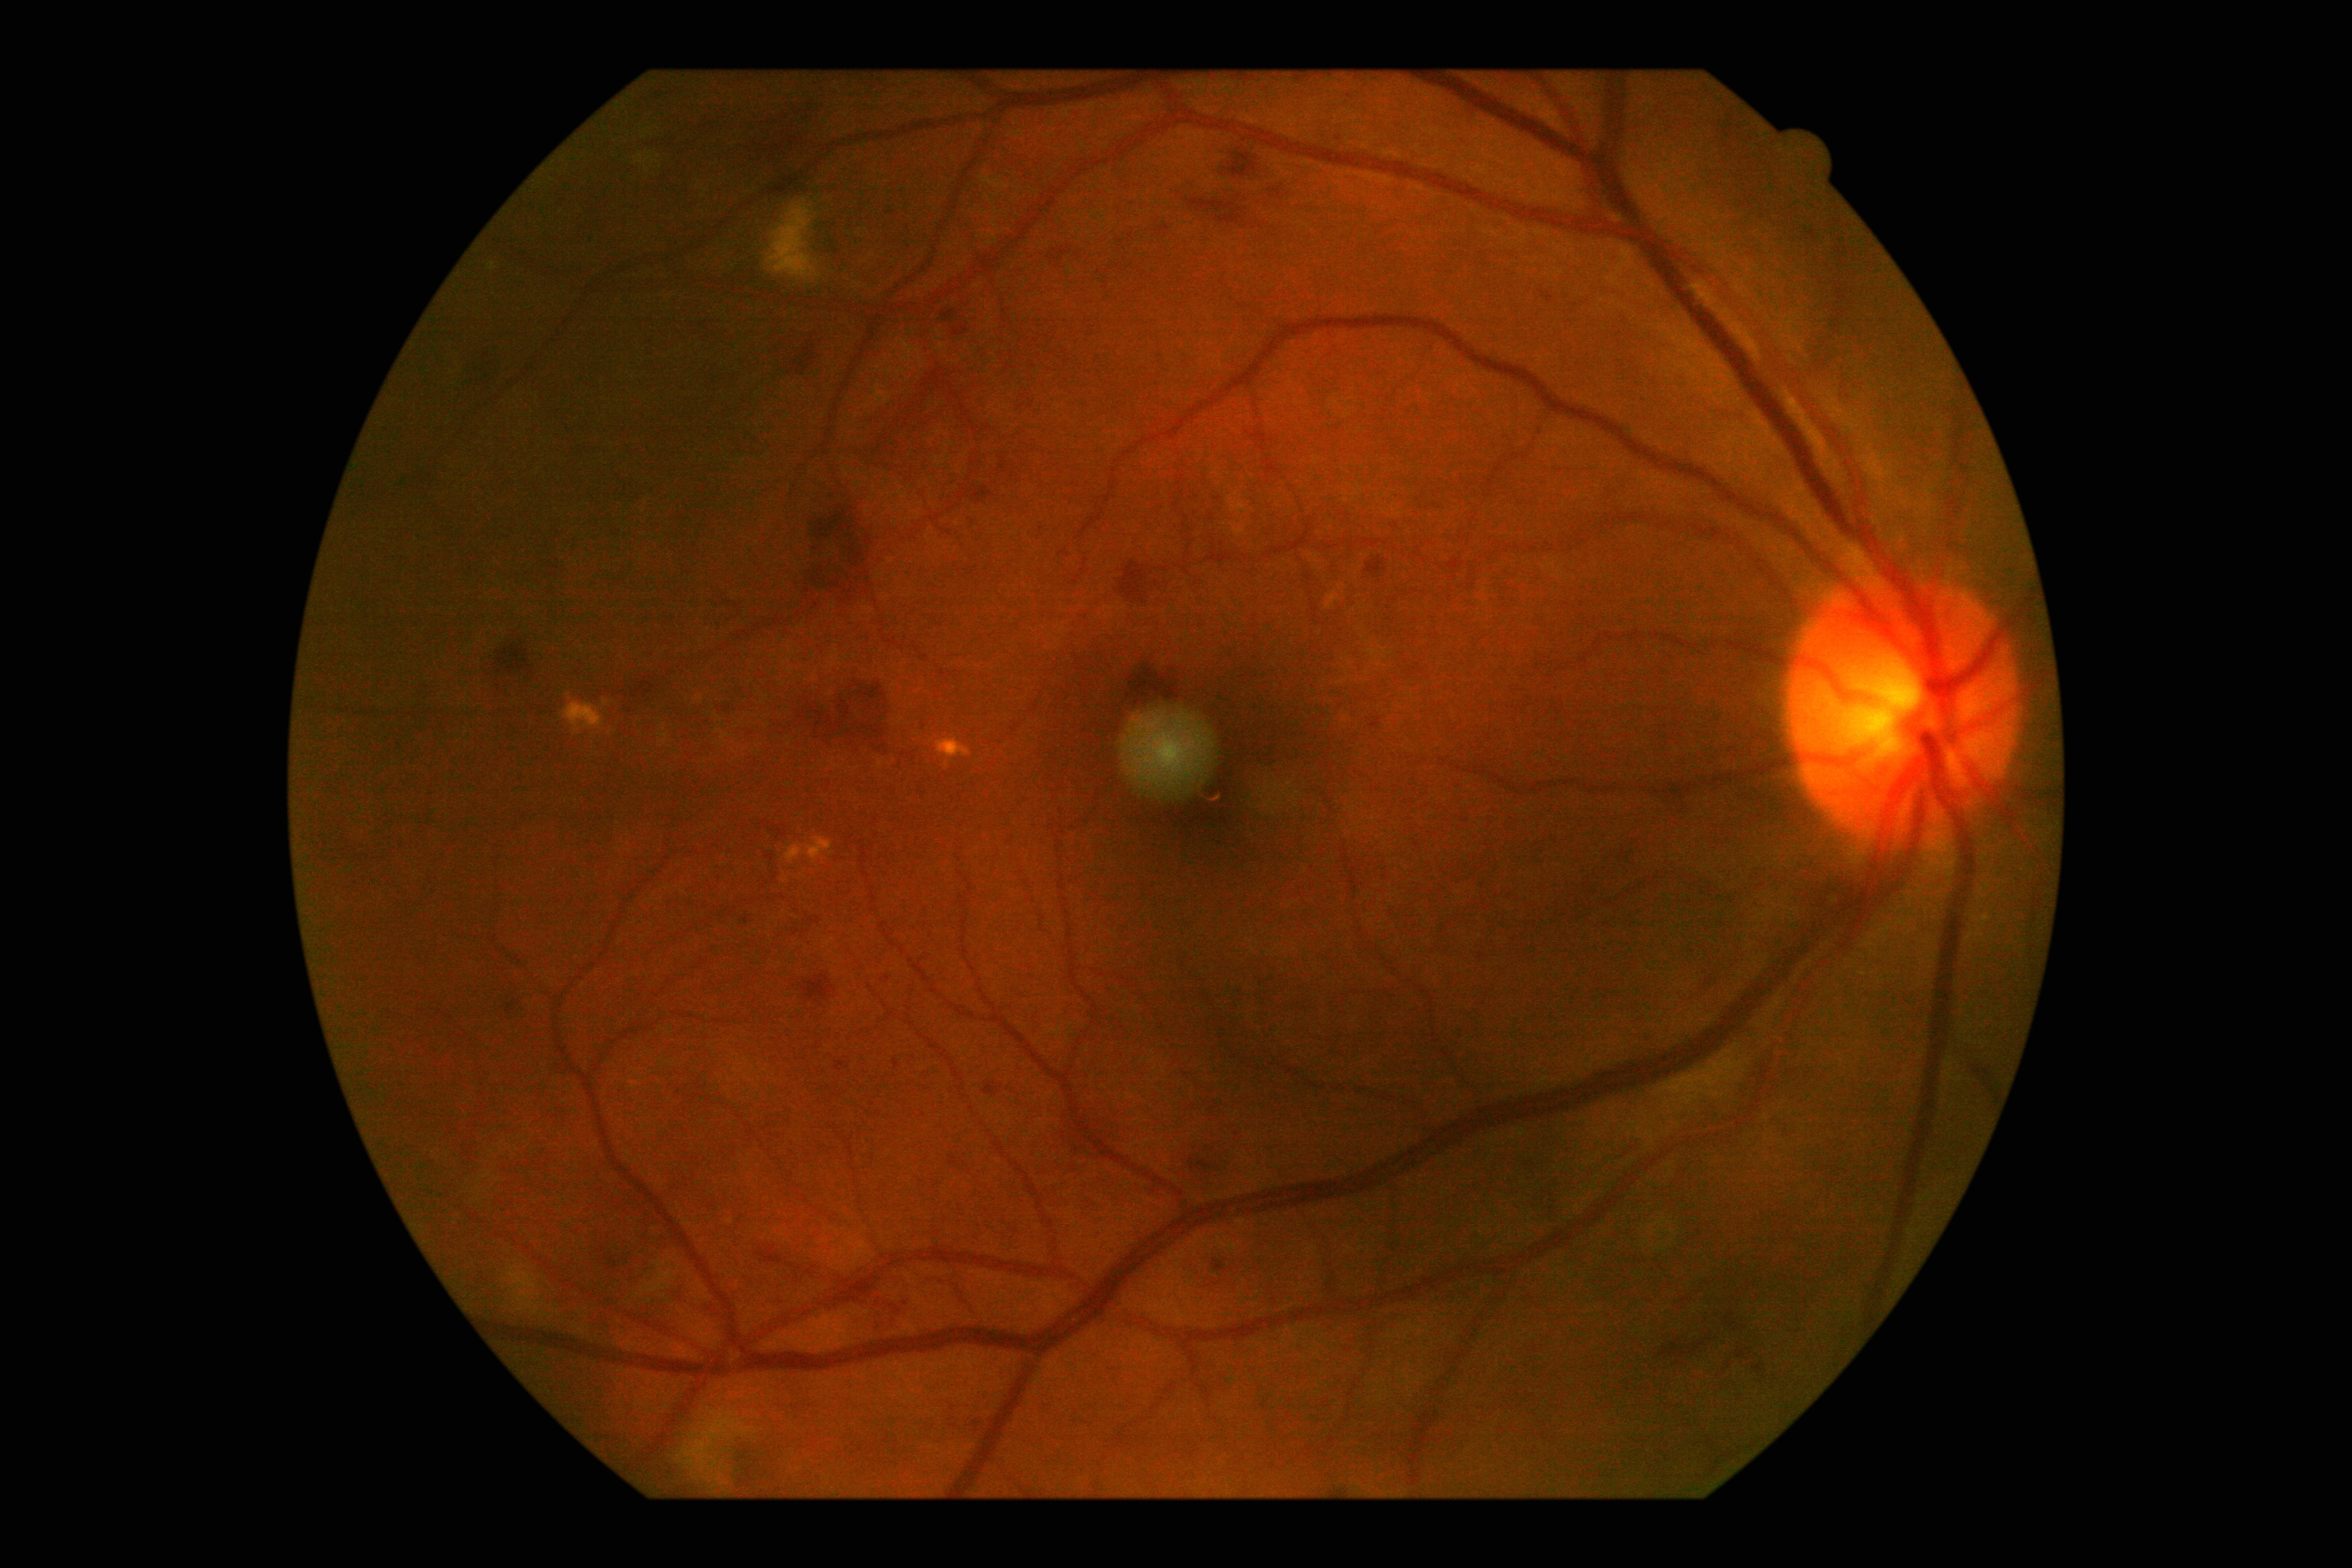 Retinopathy grade: moderate NPDR (2). The retinopathy is classified as non-proliferative diabetic retinopathy.